2352 by 1568 pixels:
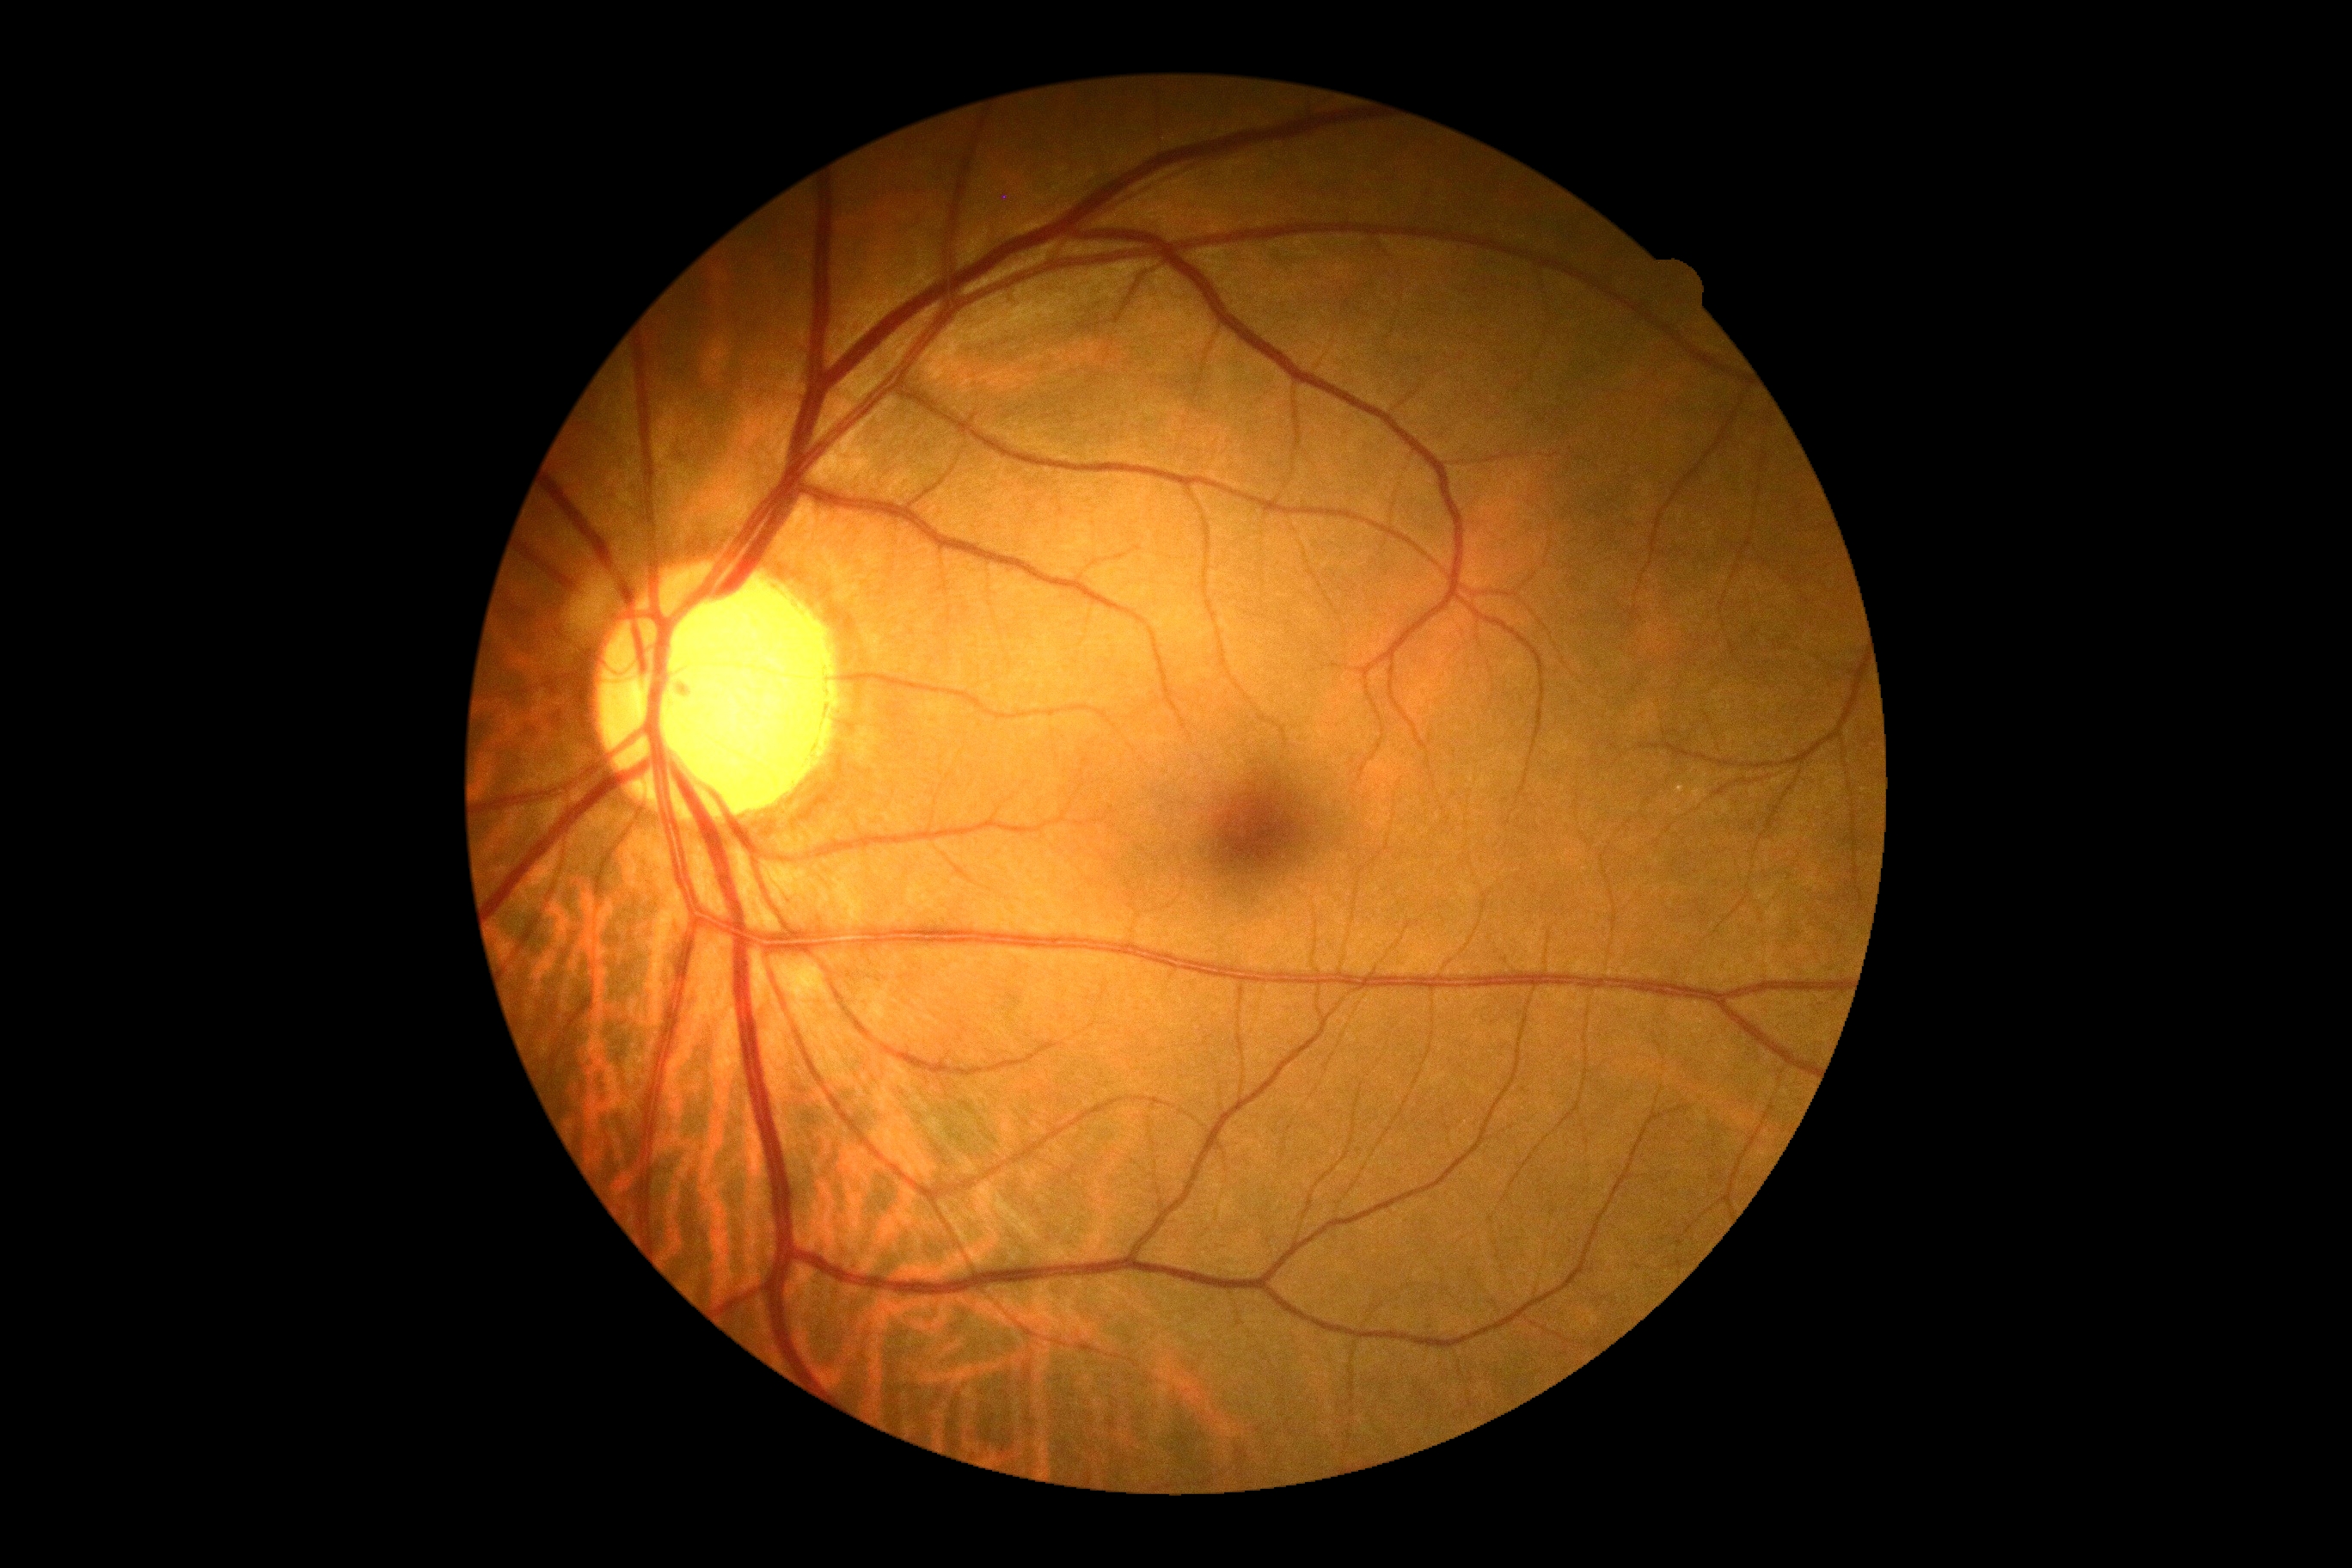

diabetic retinopathy grade: 0; DR impression: no DR findings.